Pediatric wide-field fundus photograph; camera: Clarity RetCam 3 (130° FOV)
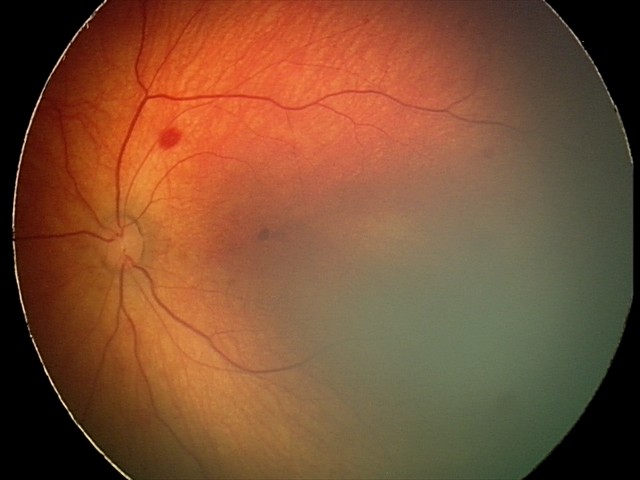
Diagnosis from this screening exam: retinal hemorrhages.